848x848:
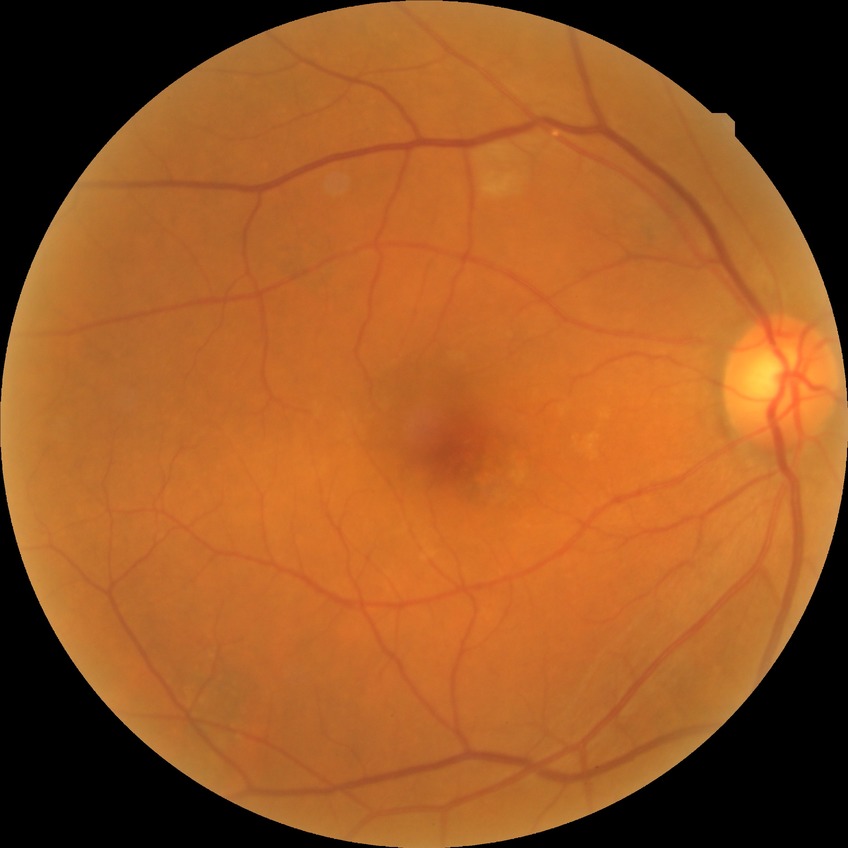

Diabetic retinopathy (DR): NDR (no diabetic retinopathy).